Image size 2352x1568:
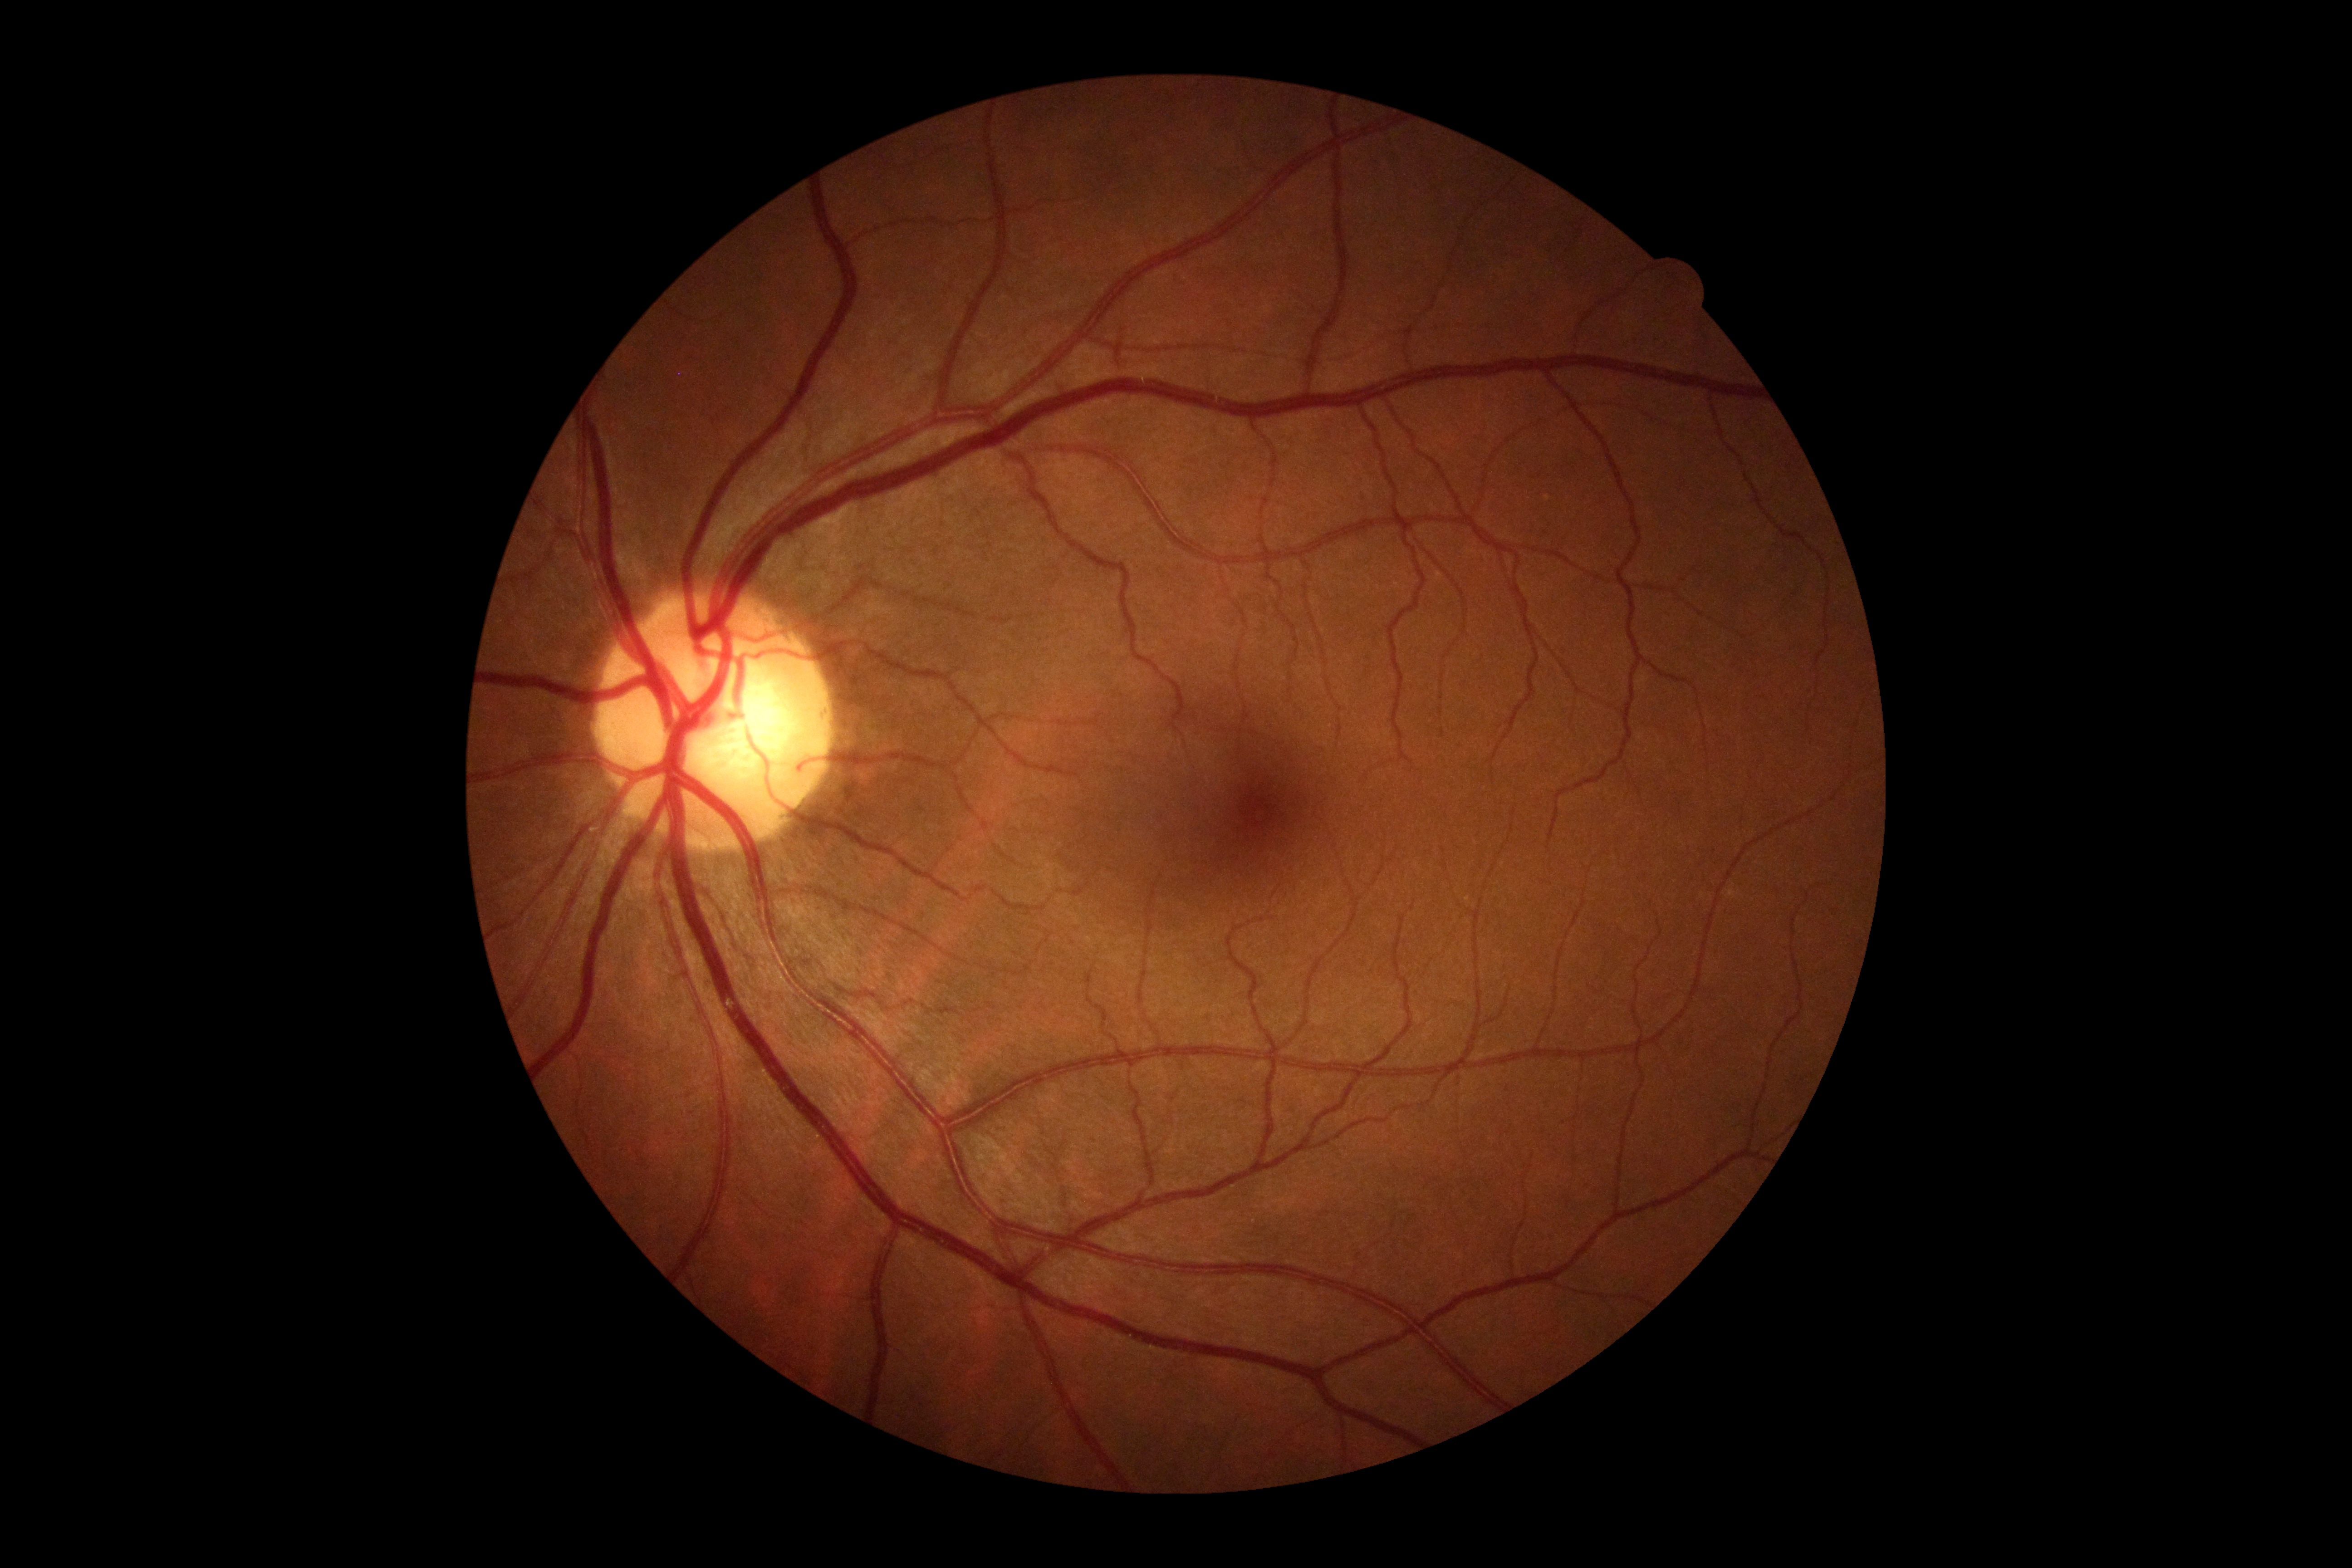 Annotations:
* retinopathy: 0/4
* DR impression: no DR findings